Infant wide-field fundus photograph:
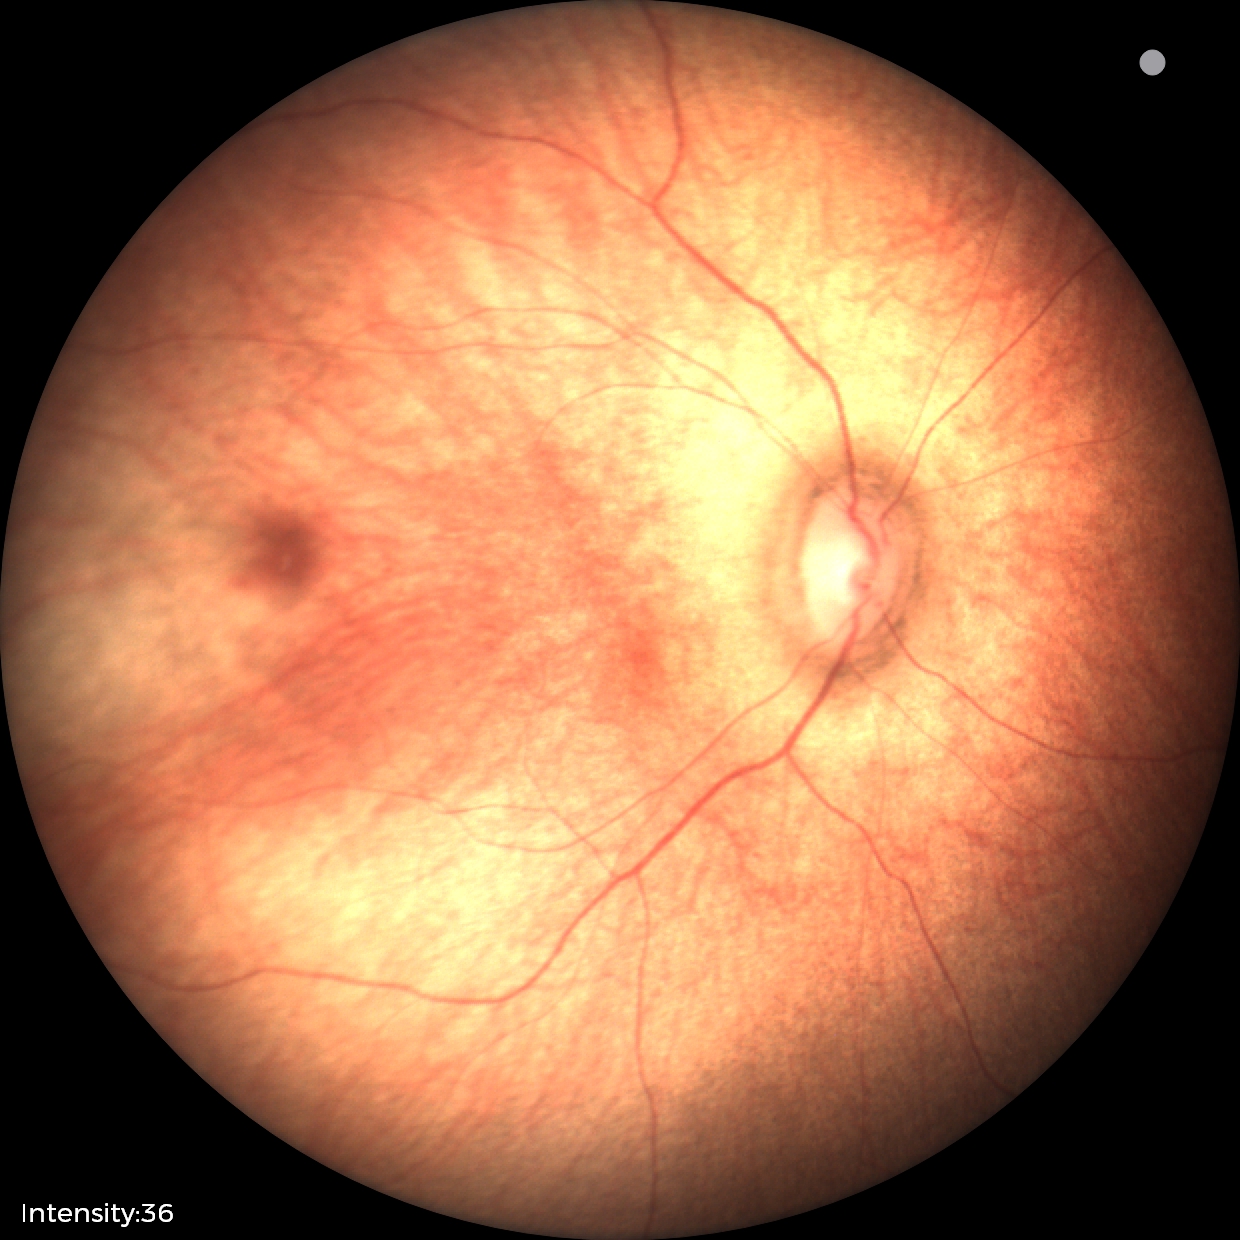

Screening diagnosis: no abnormalities.